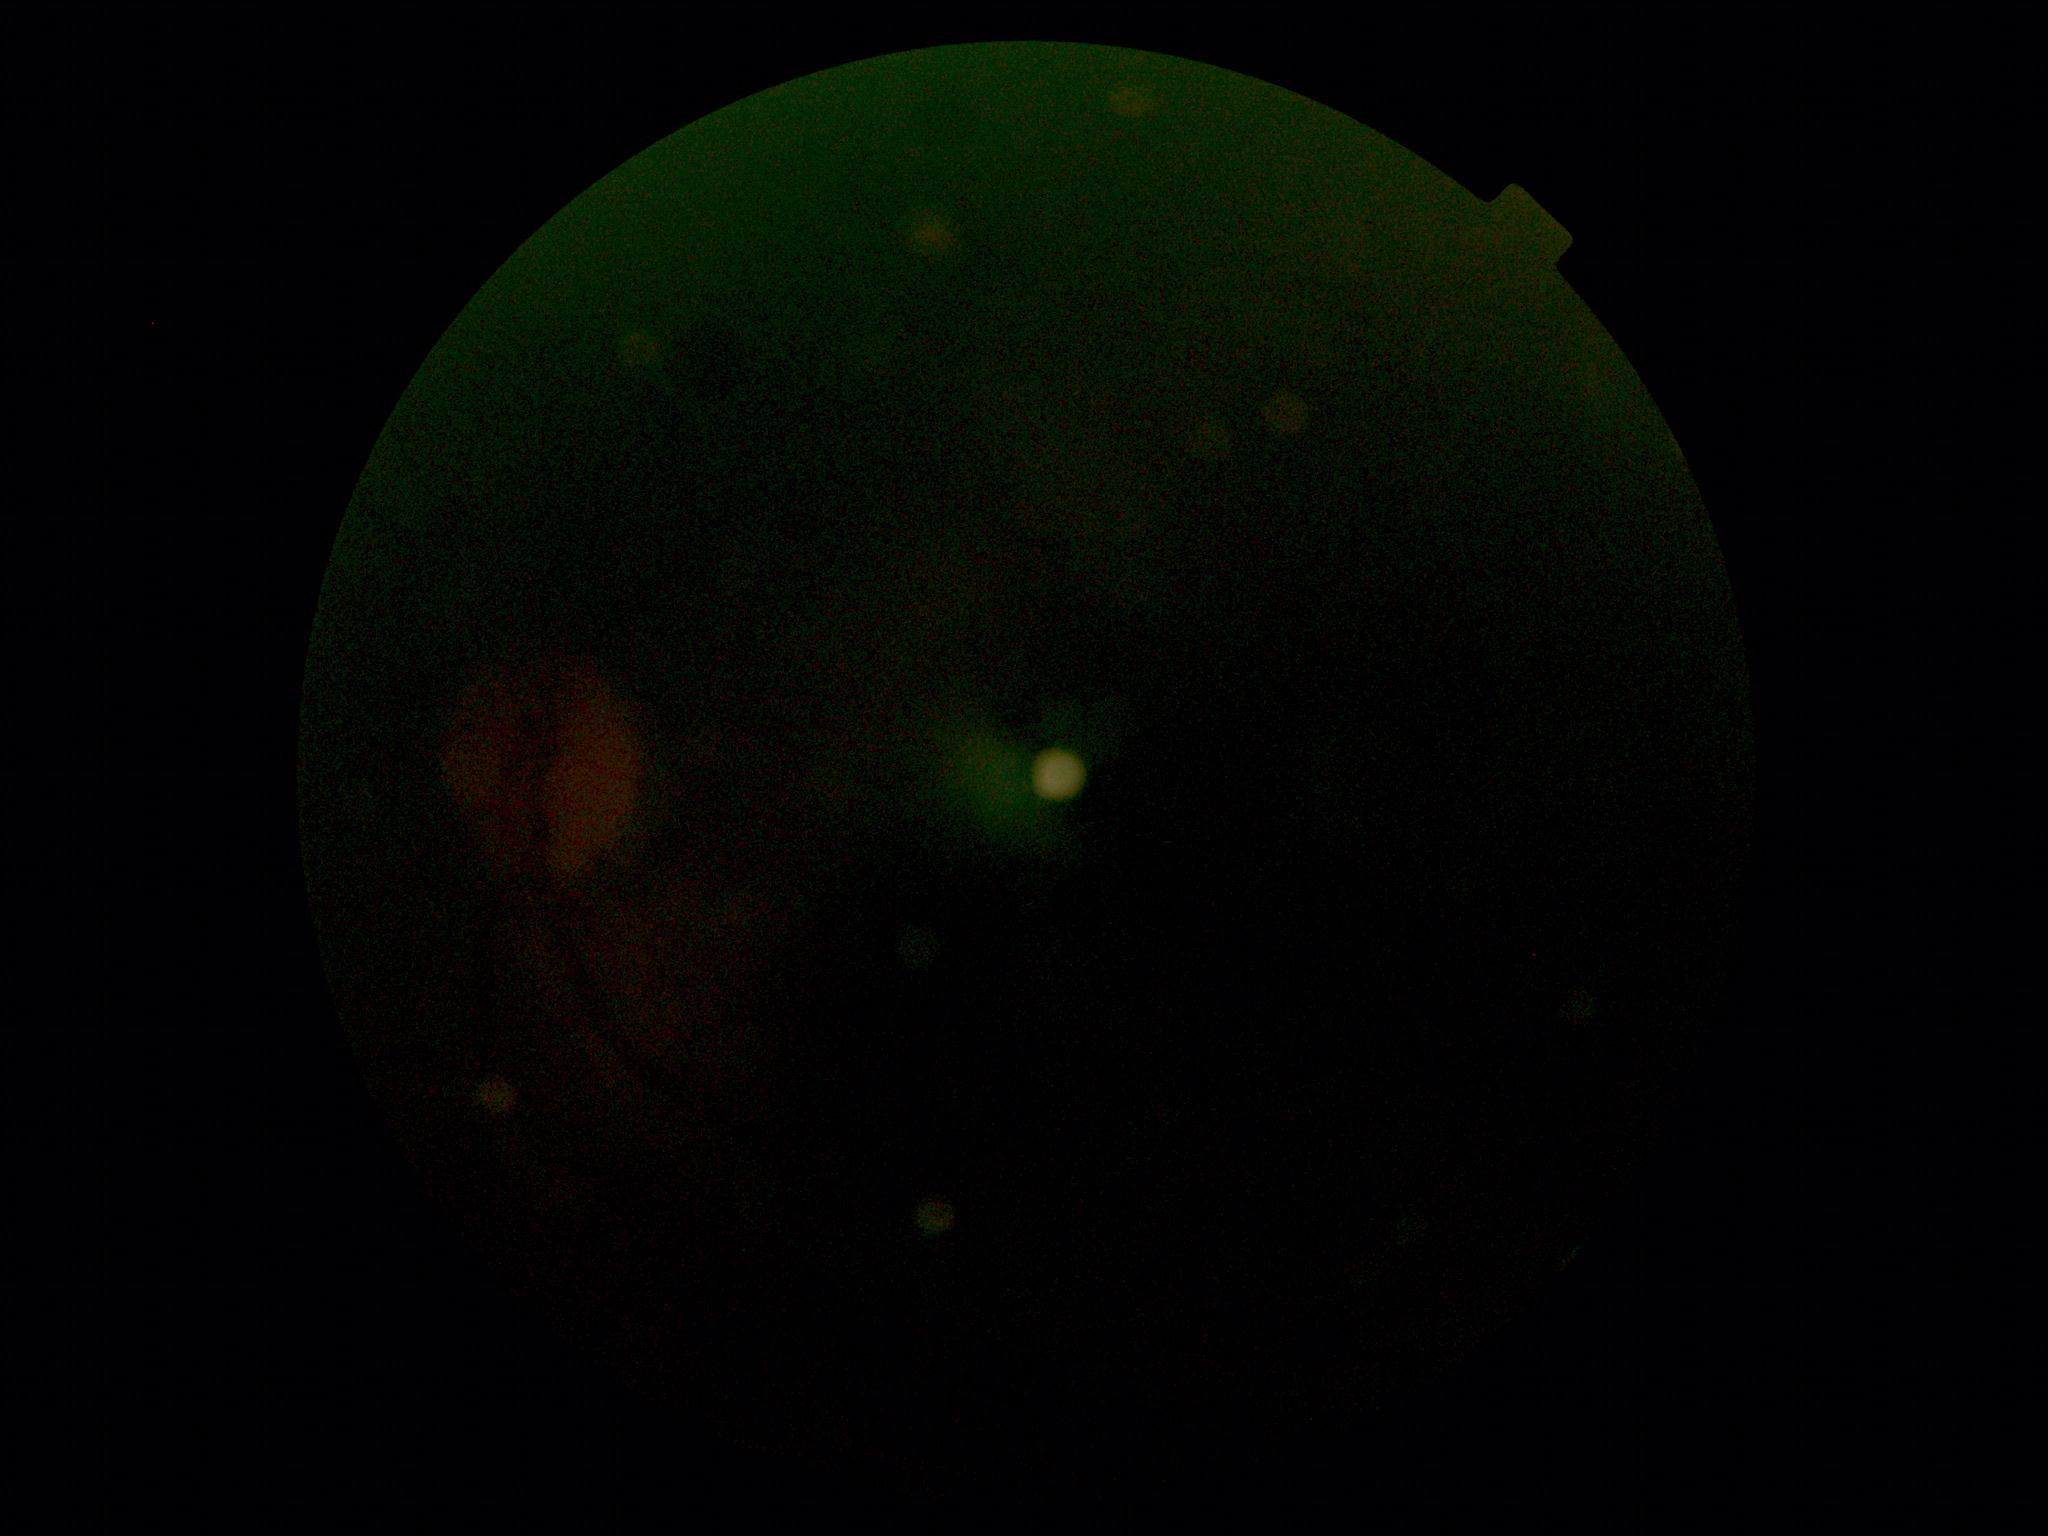

Retinopathy: ungradable. Quality too poor to assess for DR.